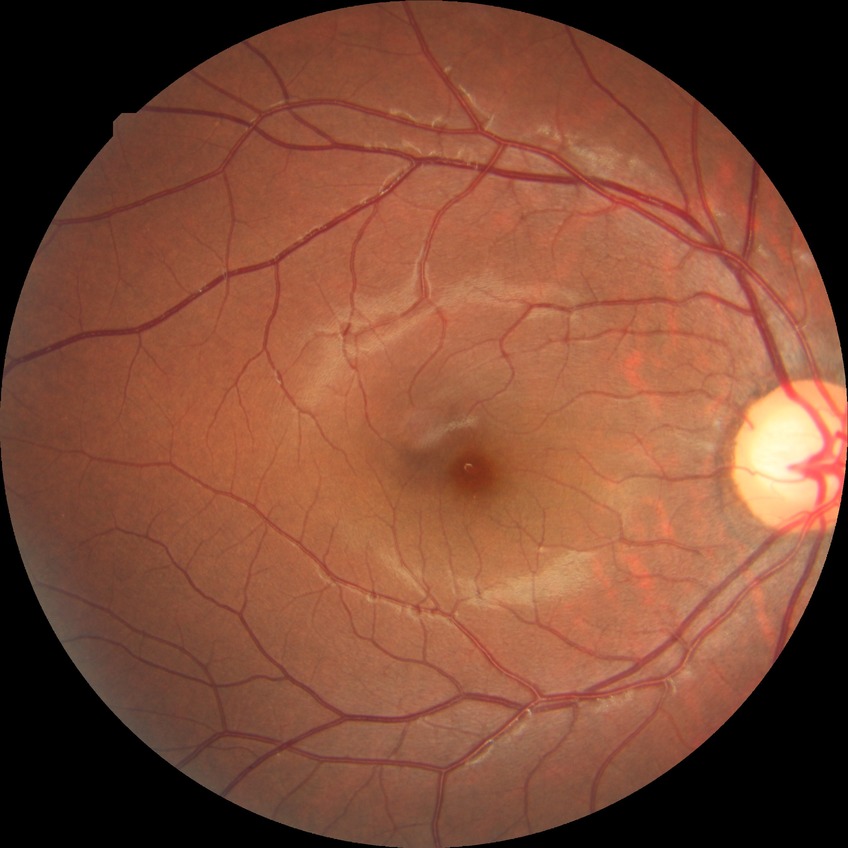
Diabetic retinopathy (DR) is no diabetic retinopathy (NDR).